FOV: 45 degrees, fundus photo — 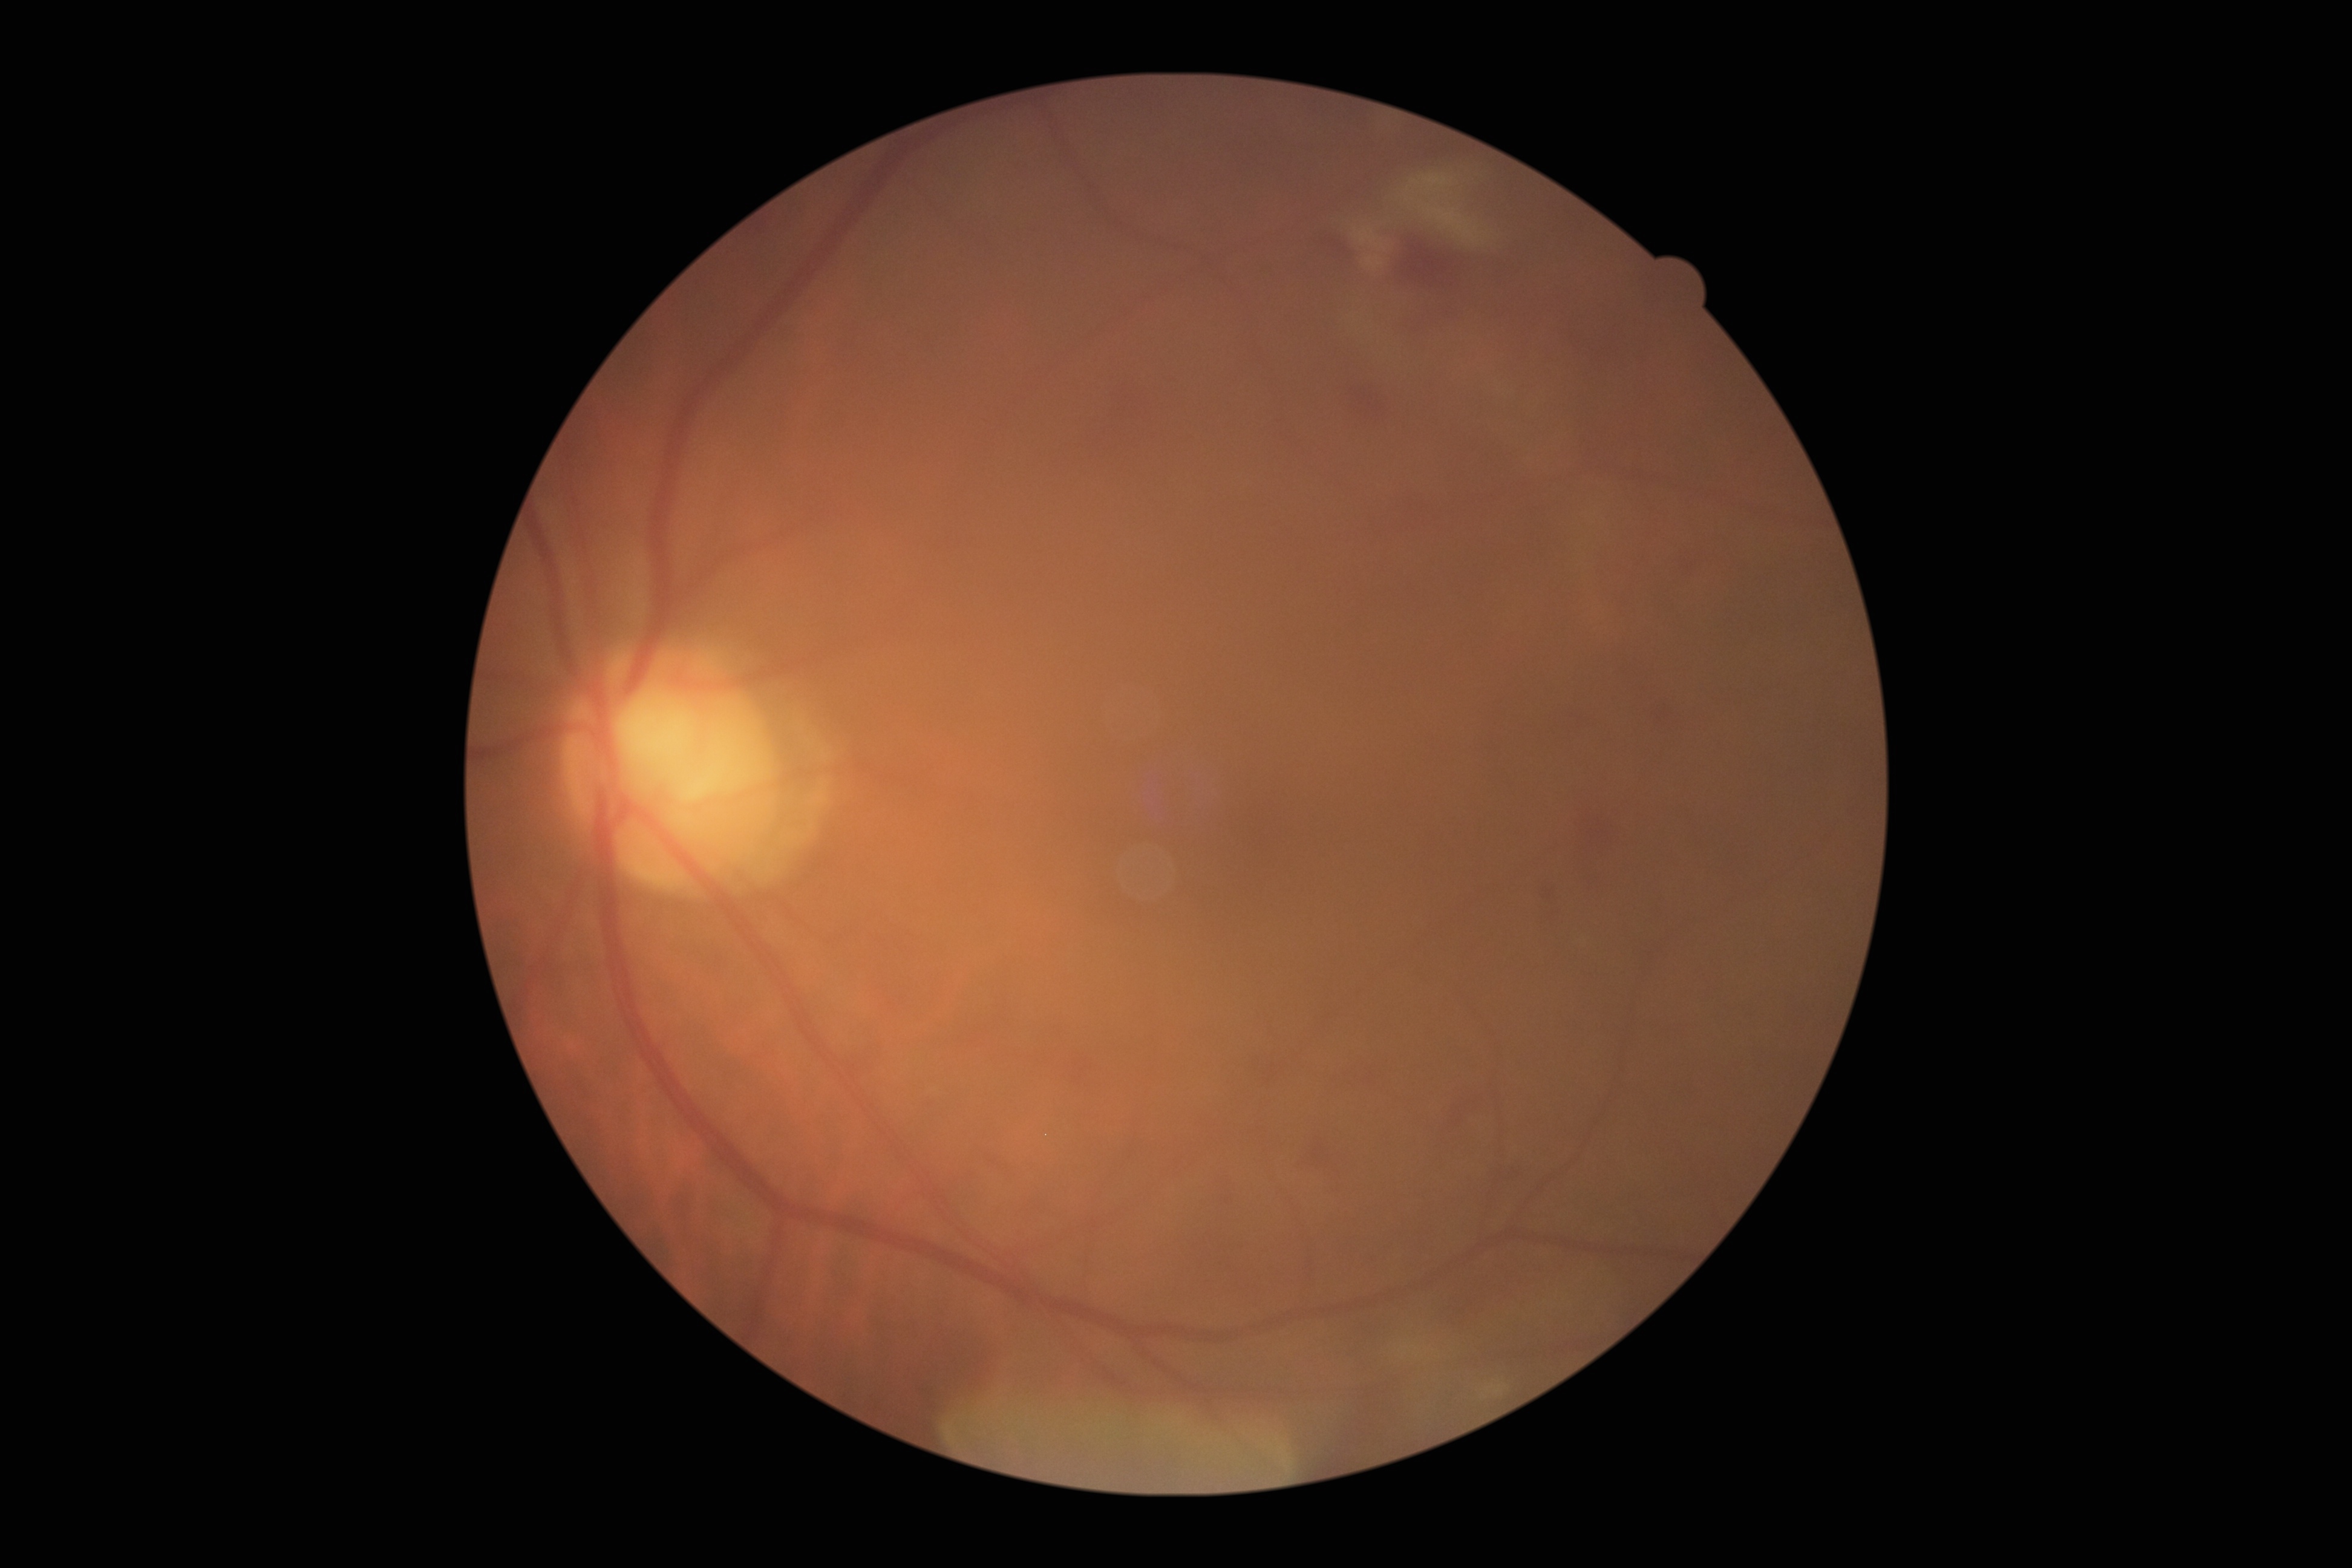 {
  "dr_grade": "grade 2"
}